Modified Davis classification
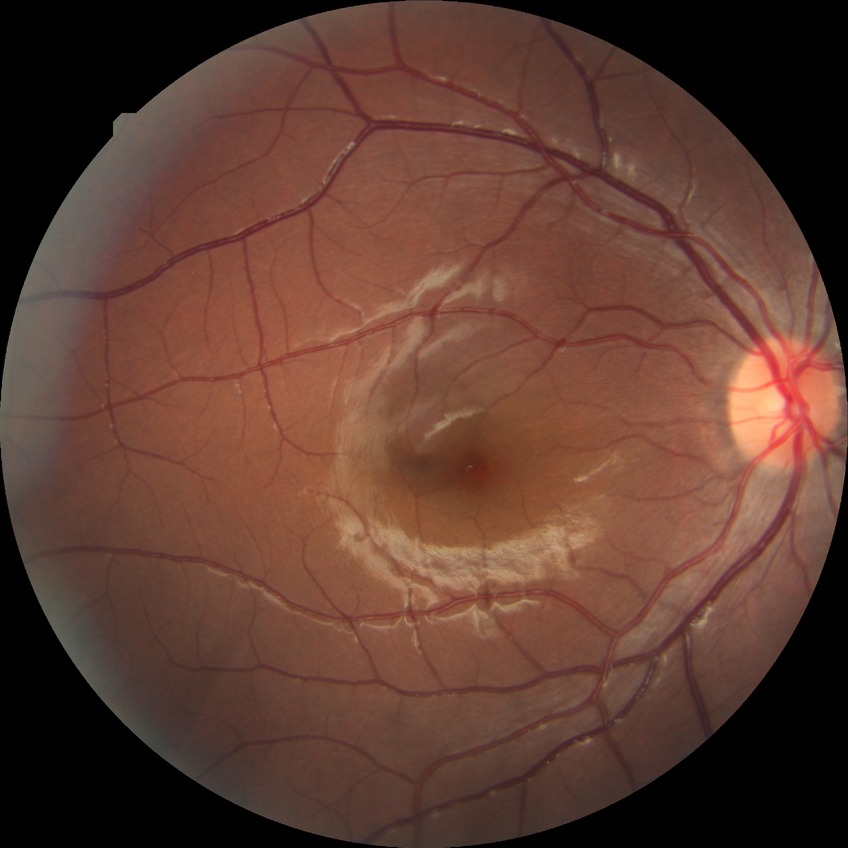

Diabetic retinopathy (DR) is no diabetic retinopathy (NDR).